848x848px, NIDEK AFC-230 — 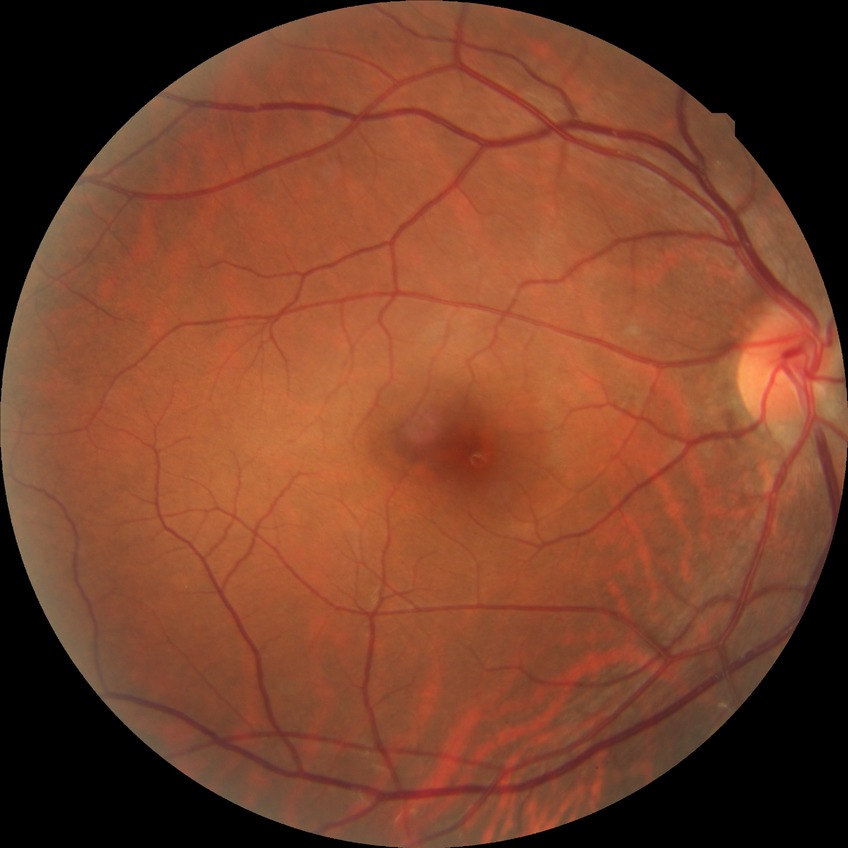
Diabetic retinopathy stage is no diabetic retinopathy.